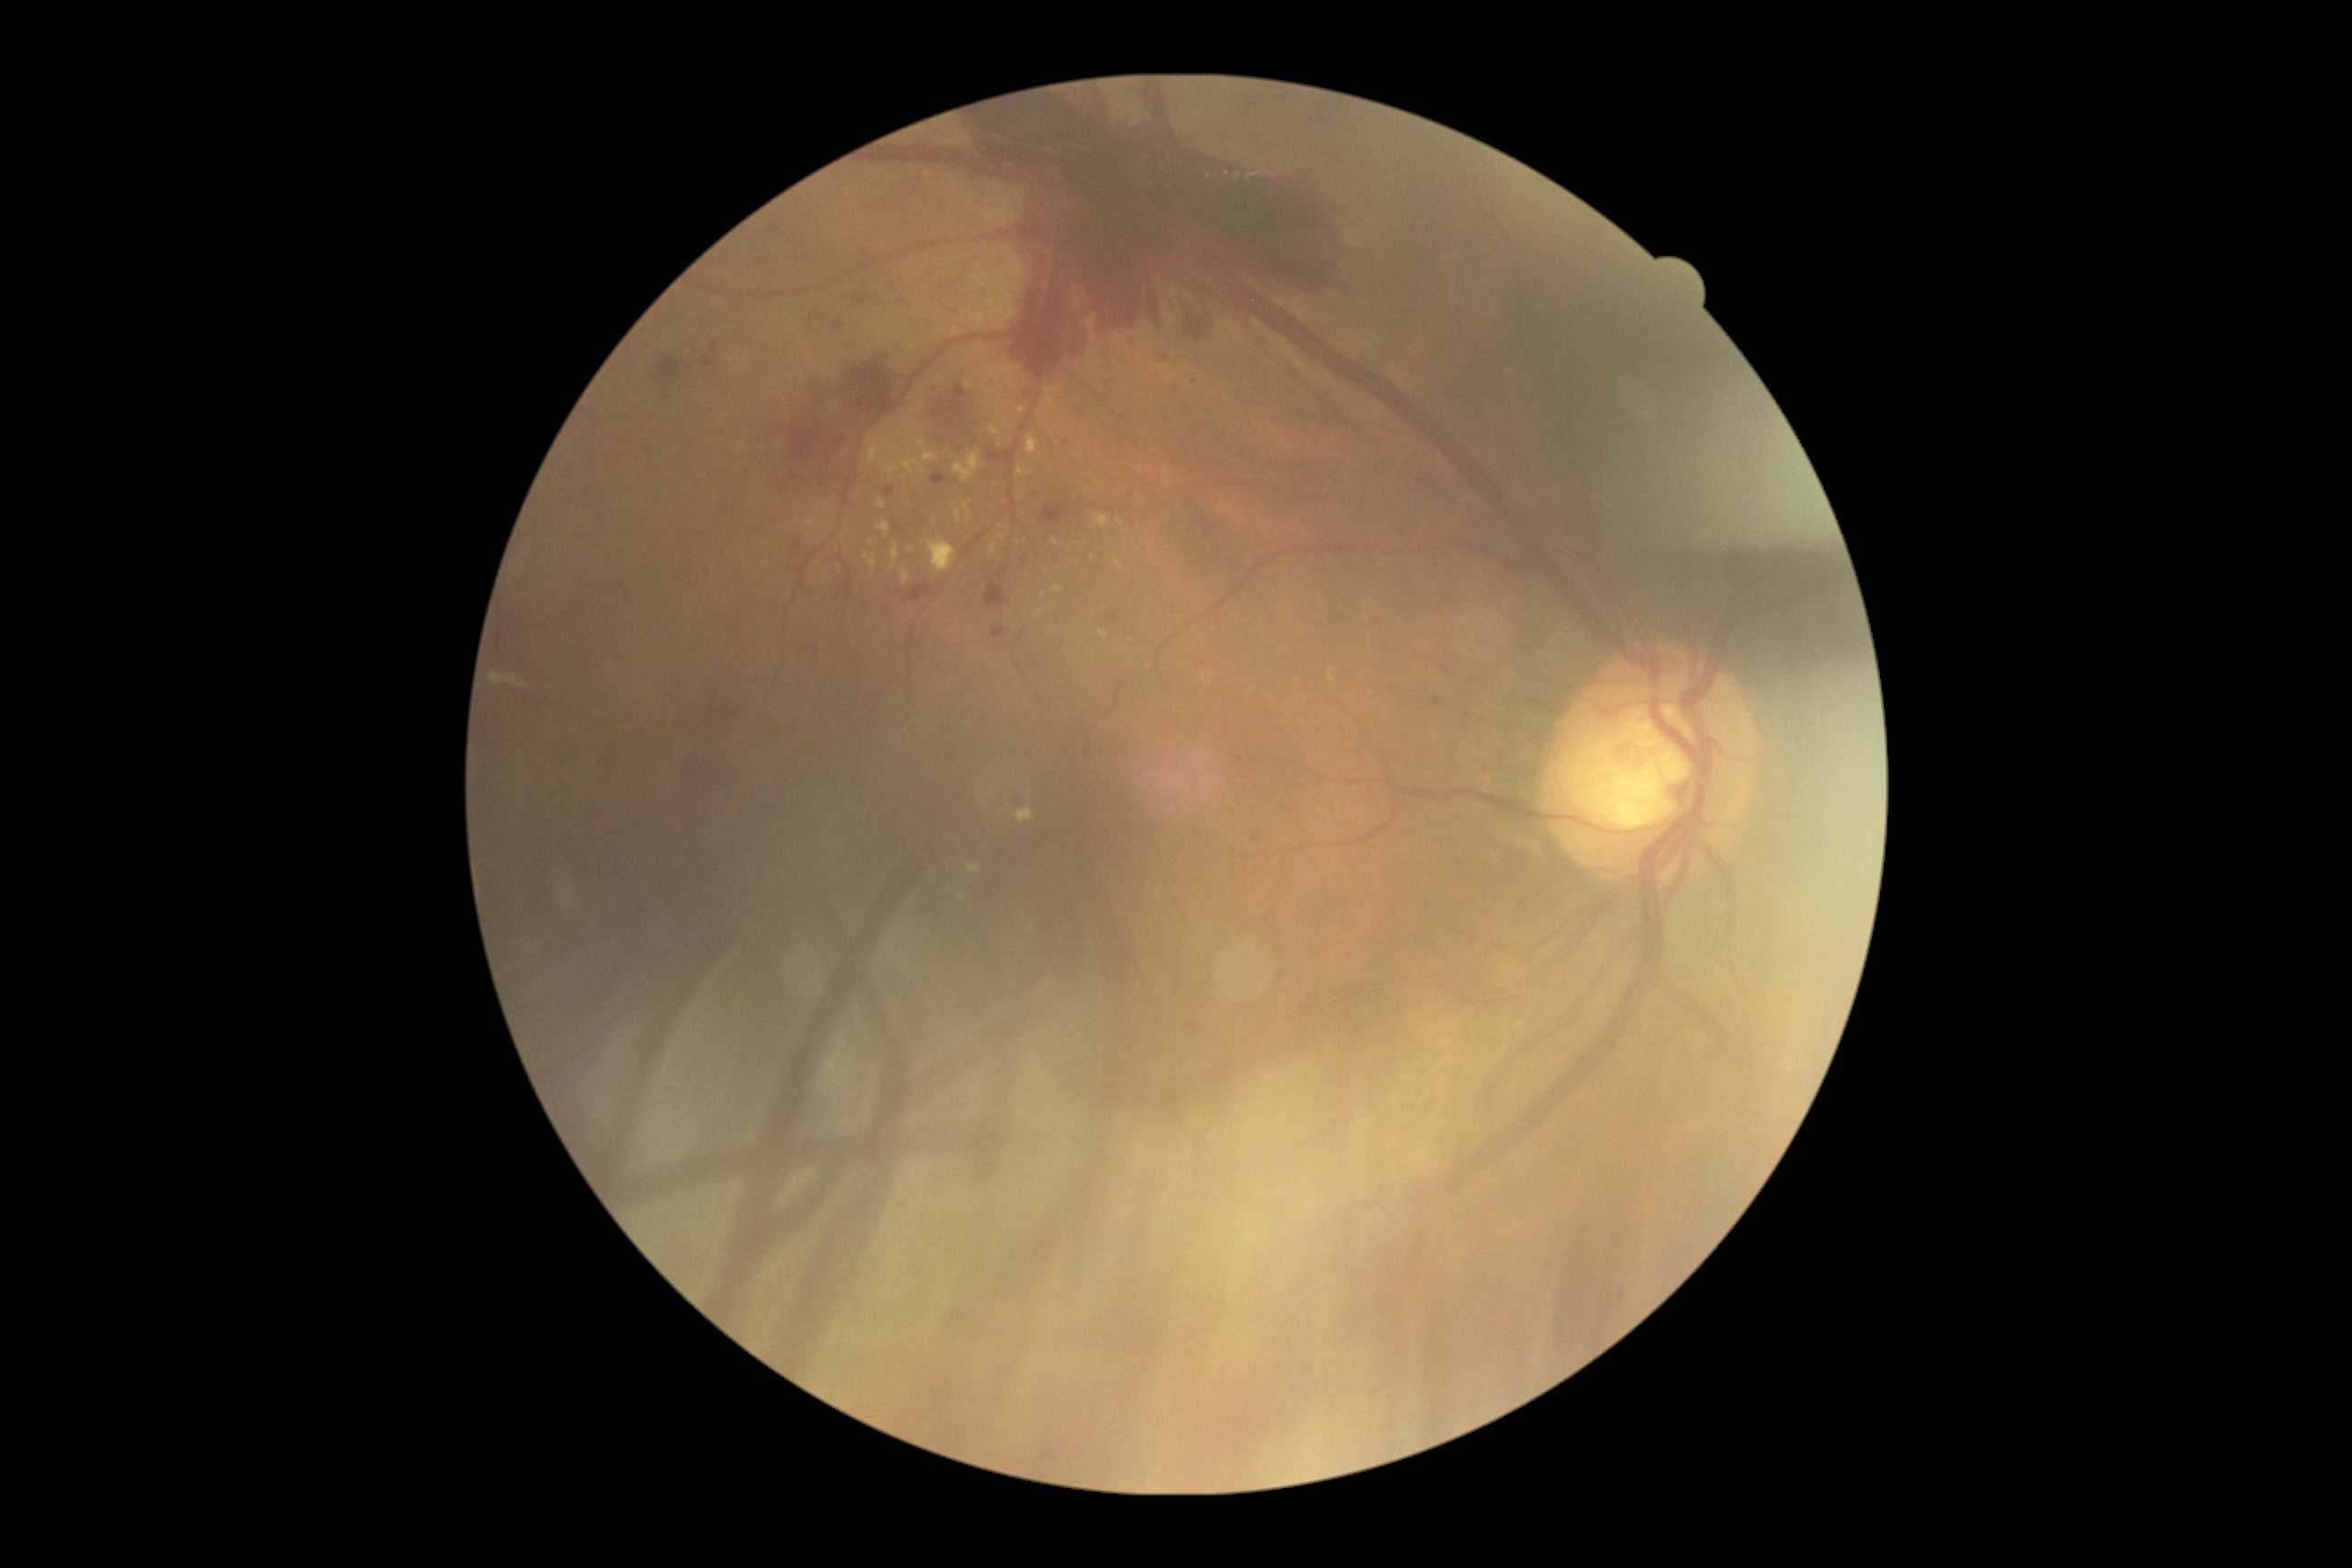 Diabetic retinopathy (DR): grade 4 (PDR).